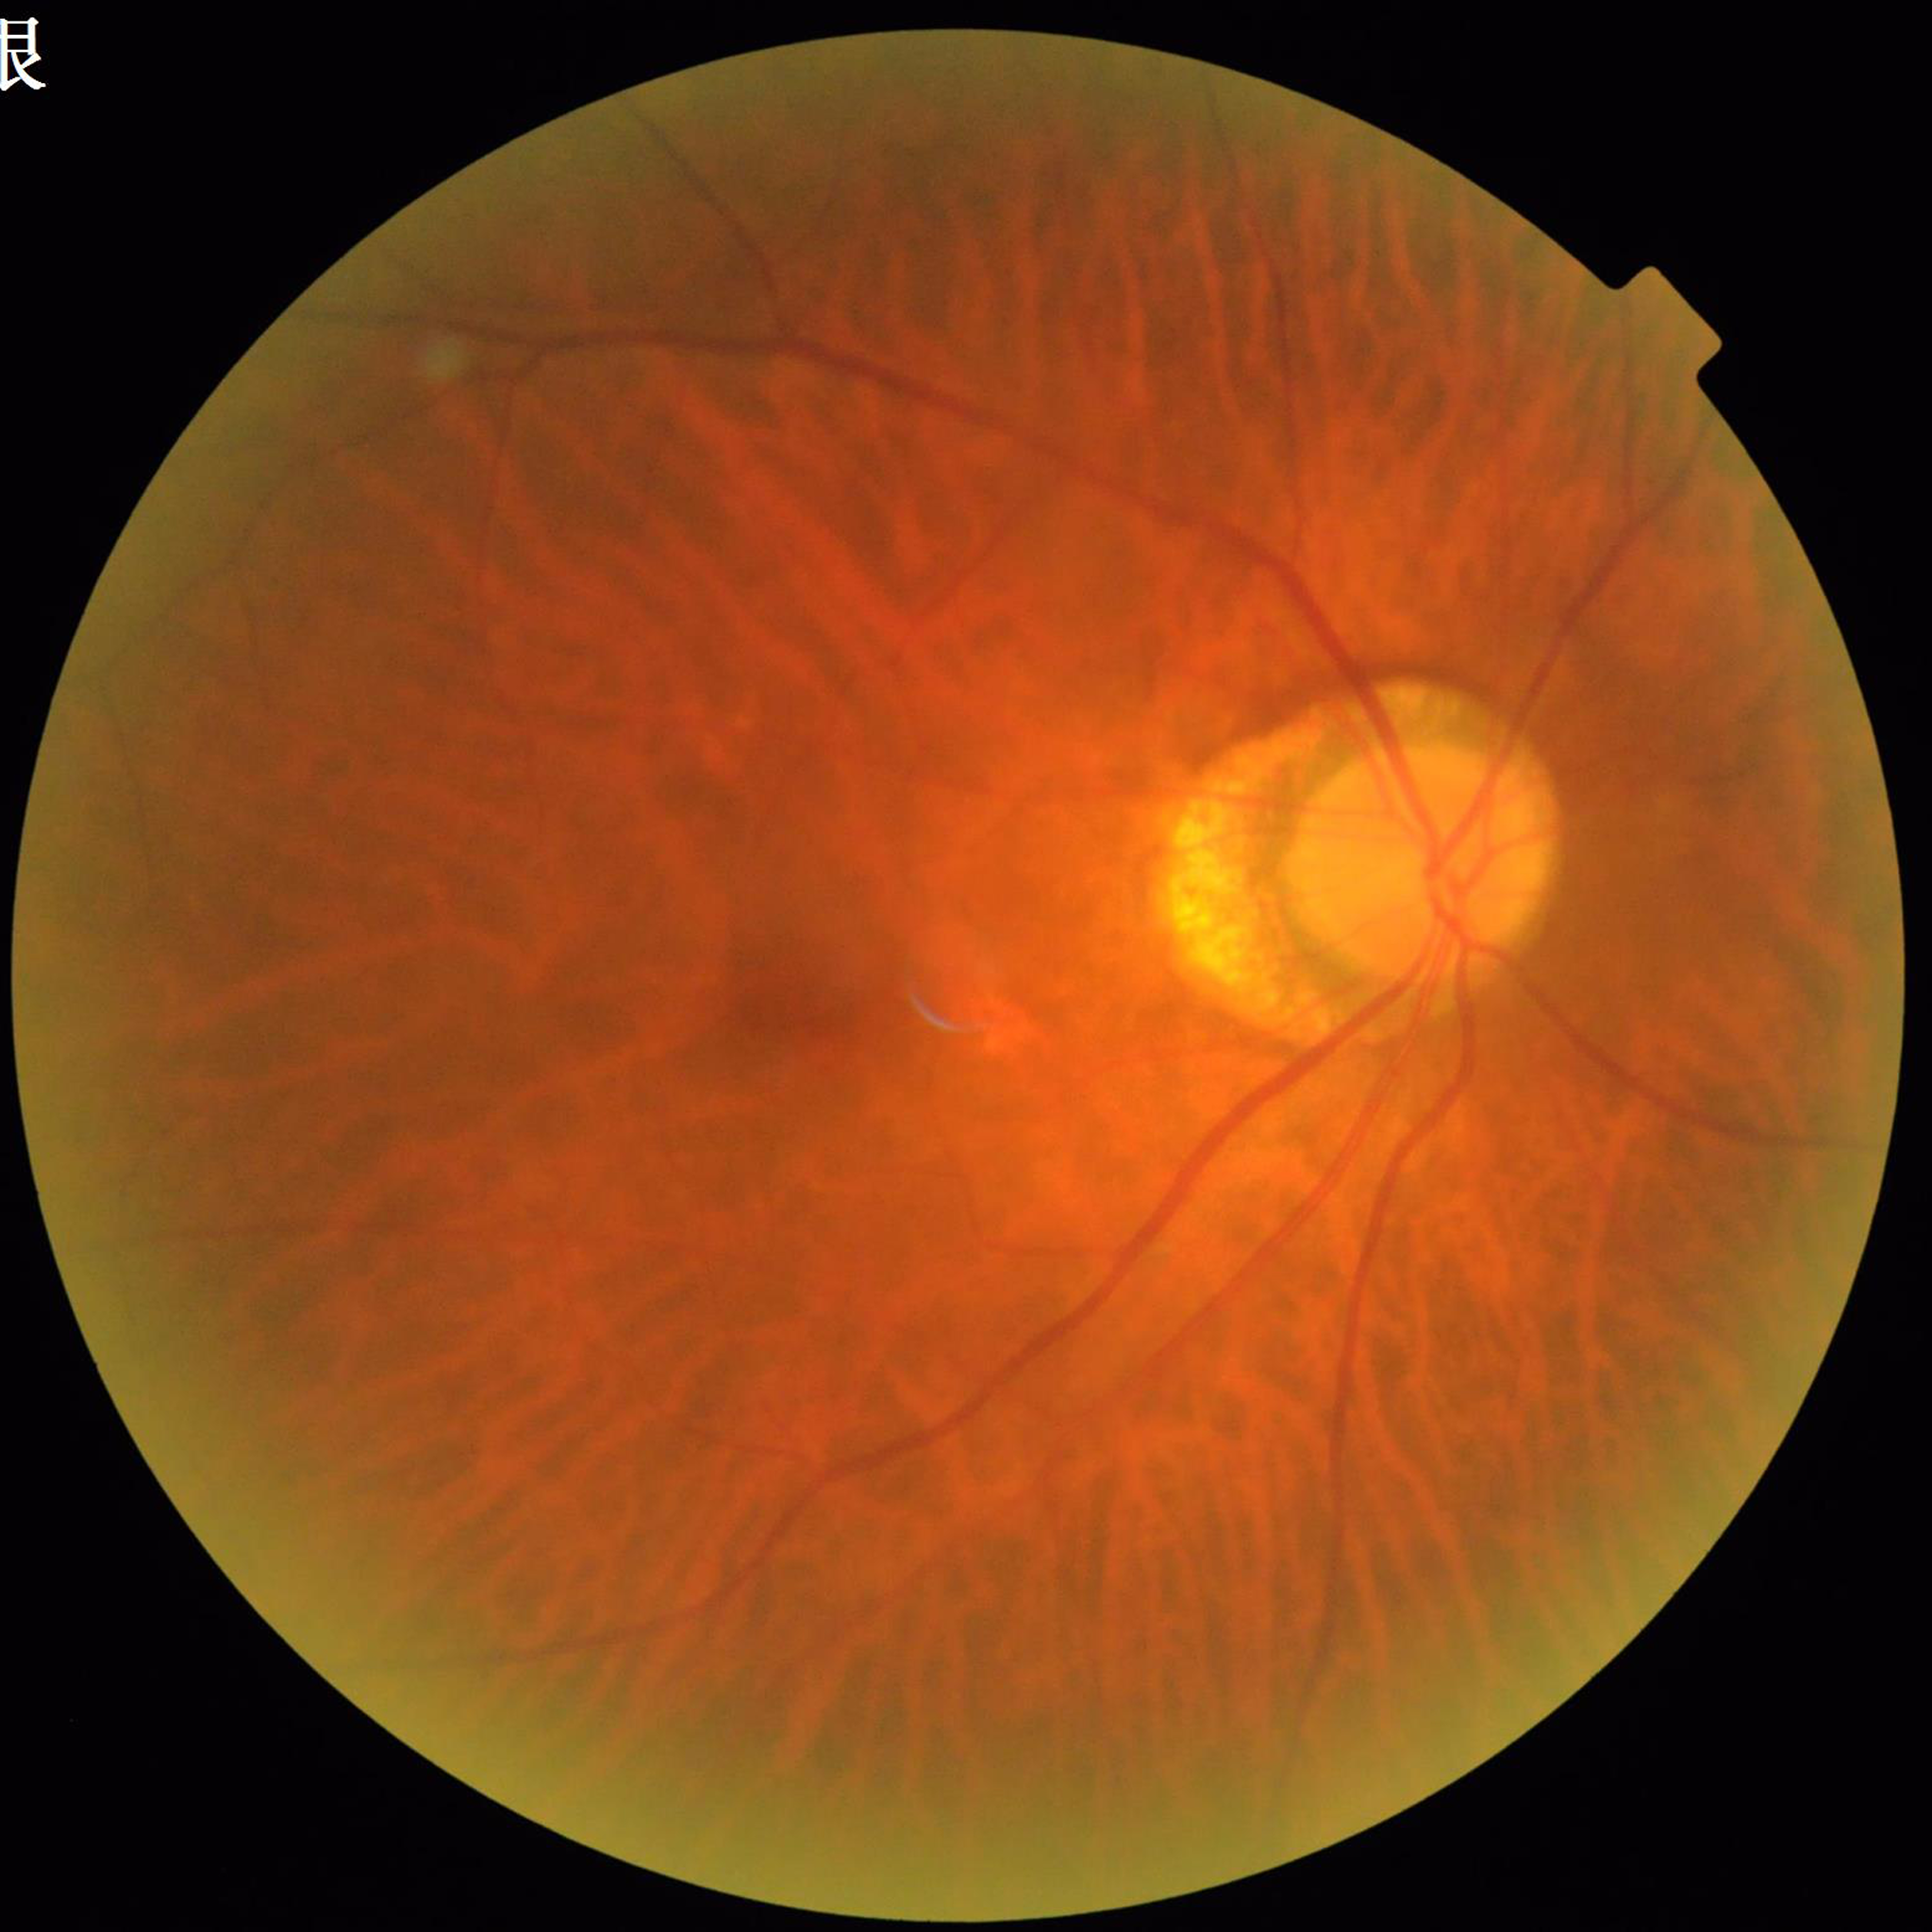

Clinical diagnosis: diabetic retinopathy.